Acquired with a Topcon TRC-NW400; pachymetry 593 µm.
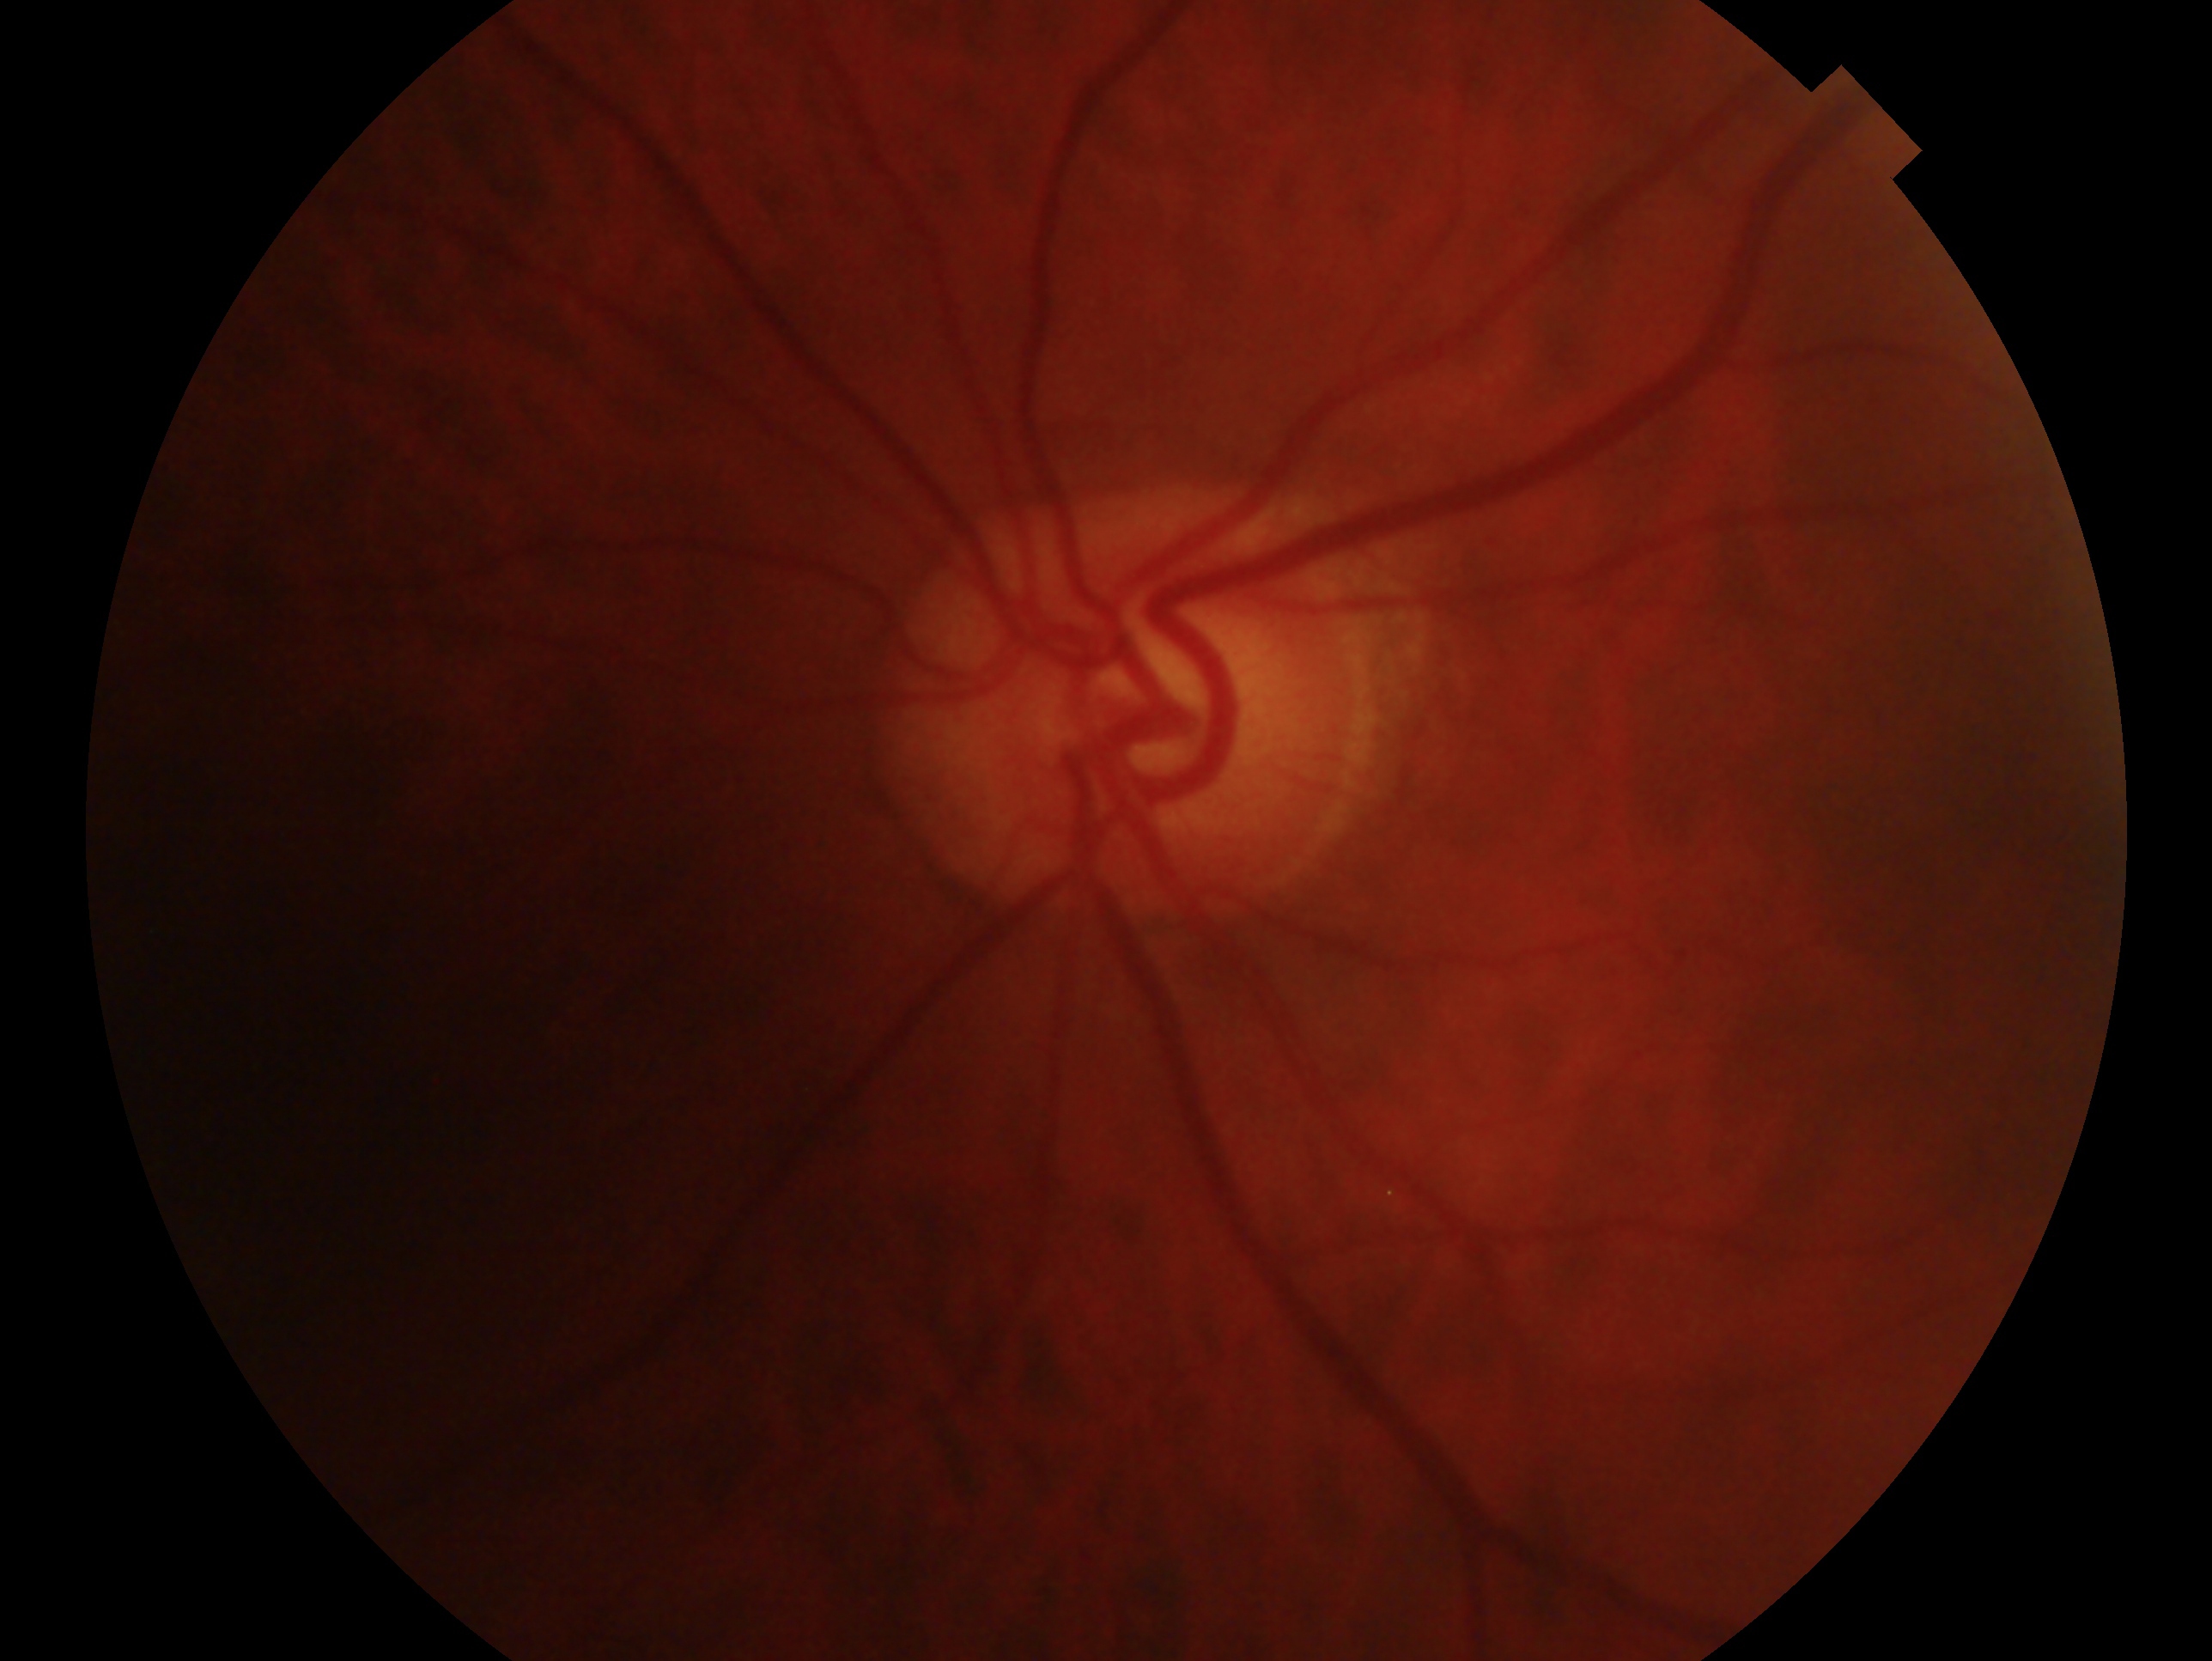 Annotations:
• laterality · left
• glaucoma status · suspicious for glaucoma